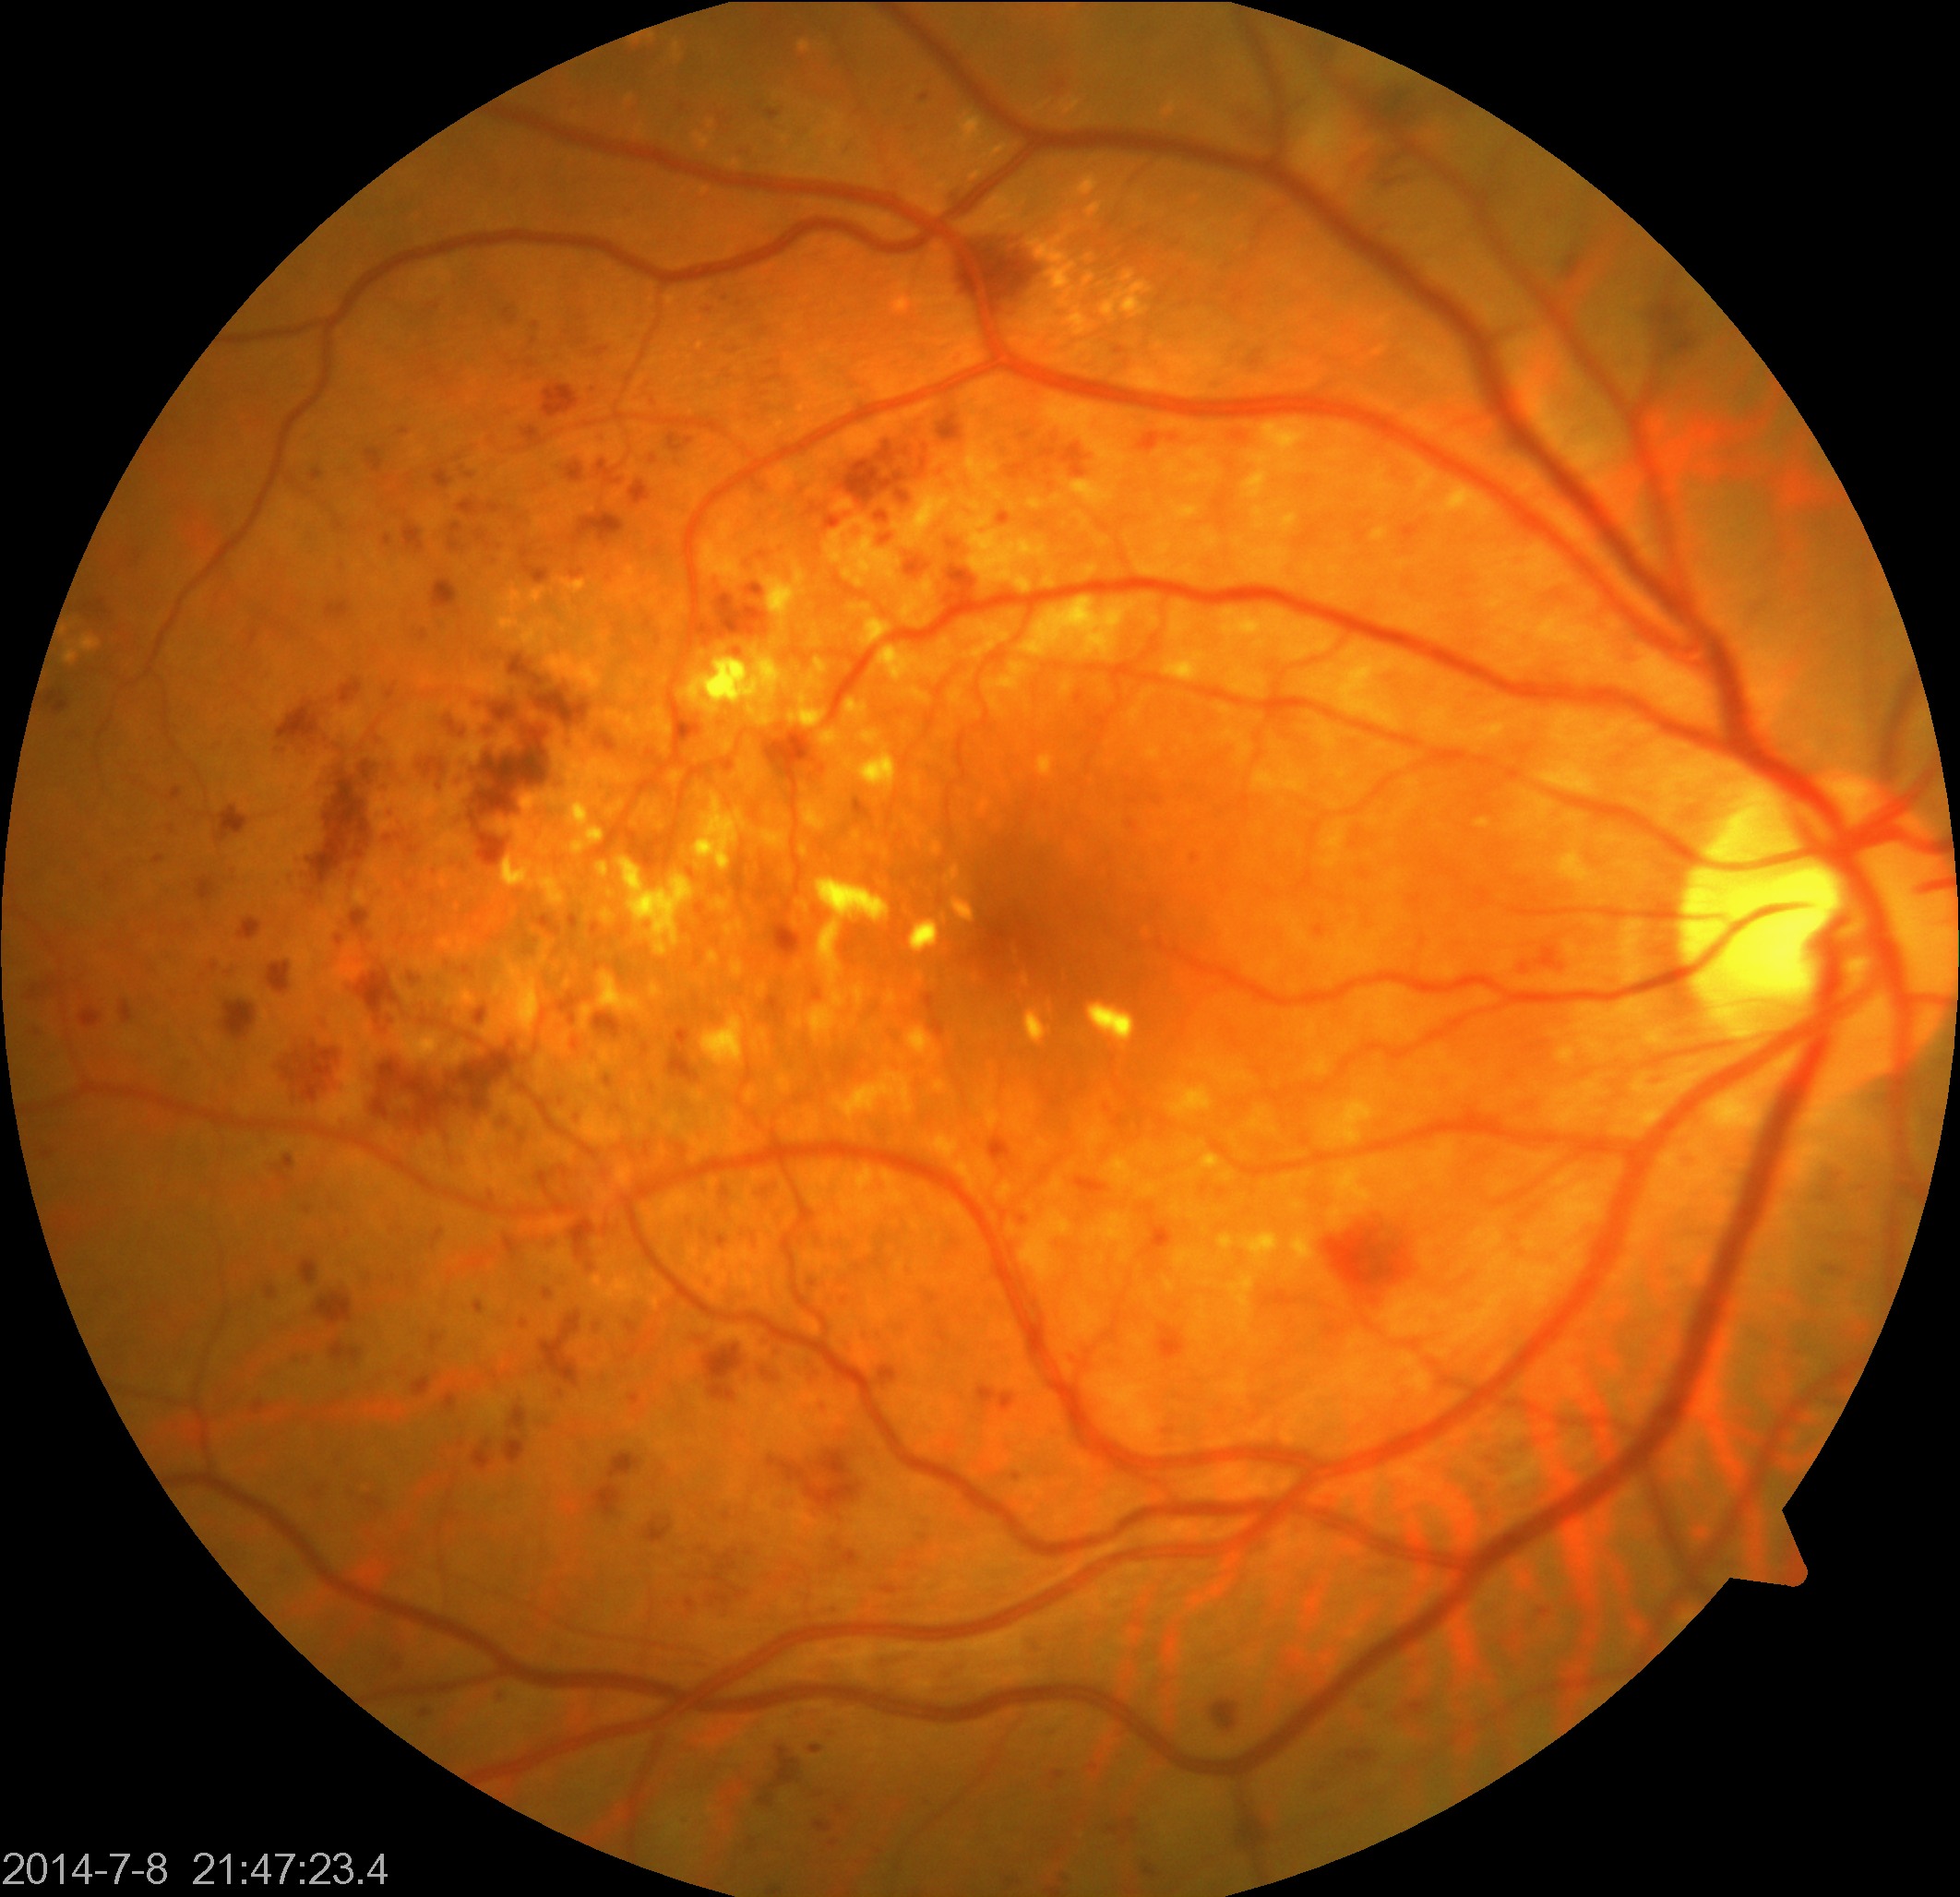

Findings: moderate non-proliferative diabetic retinopathy.